200° FOV. Ultra-widefield (UWF) fundus image. 1924x1556 — 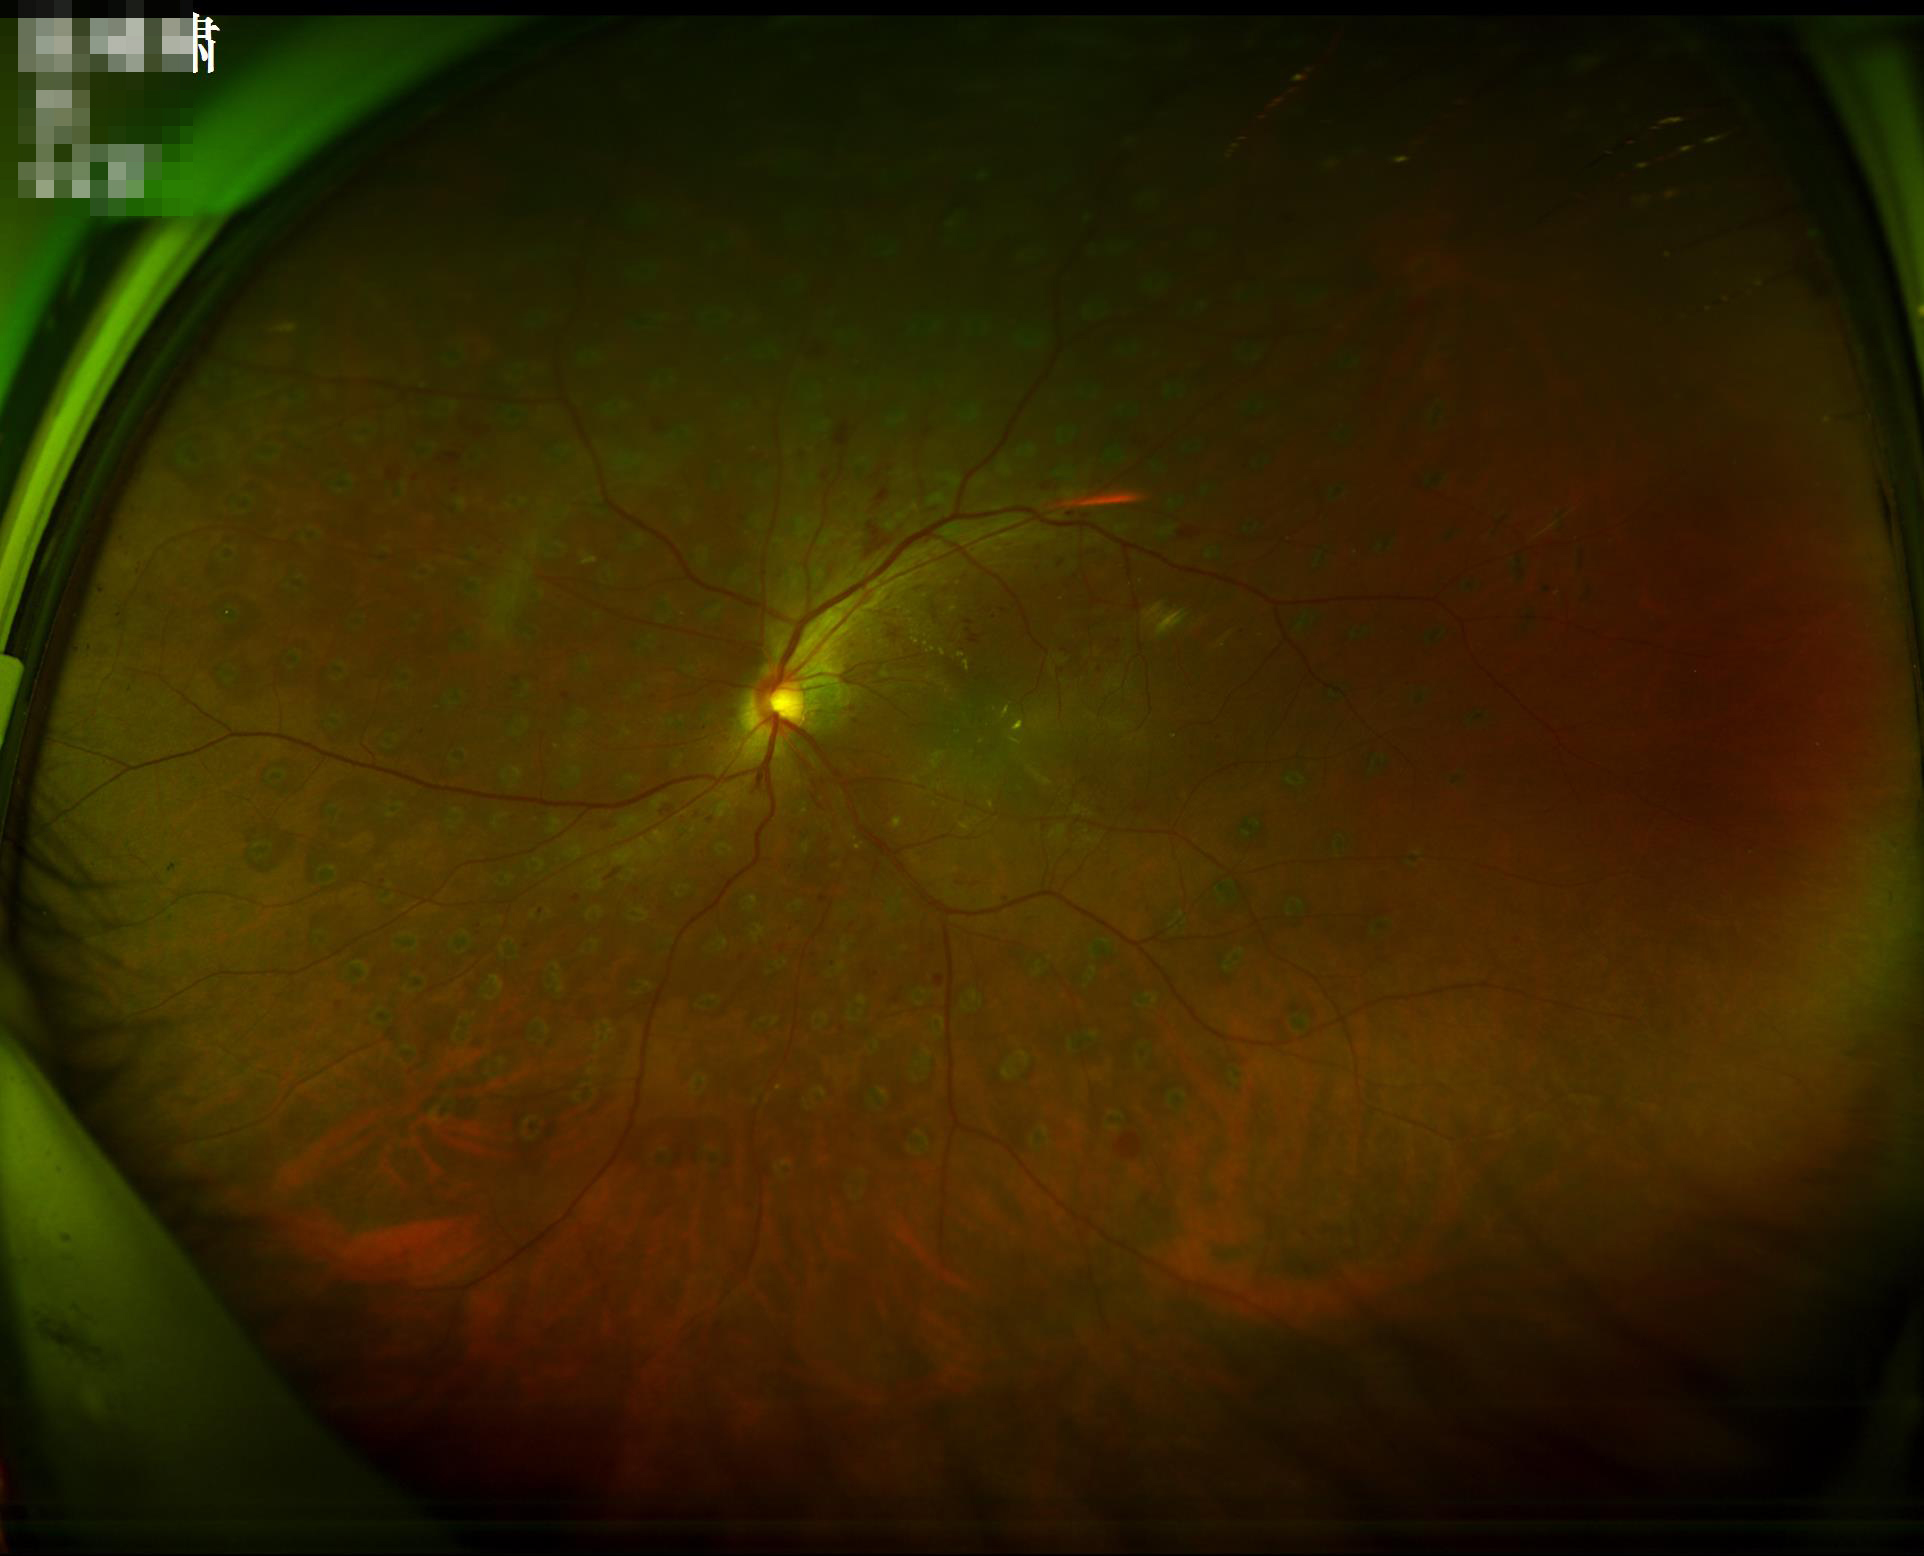

Overall quality is good and the image is gradable.
Good dynamic range.
Optic disc, vessels, and background are in focus.